Color fundus photograph.
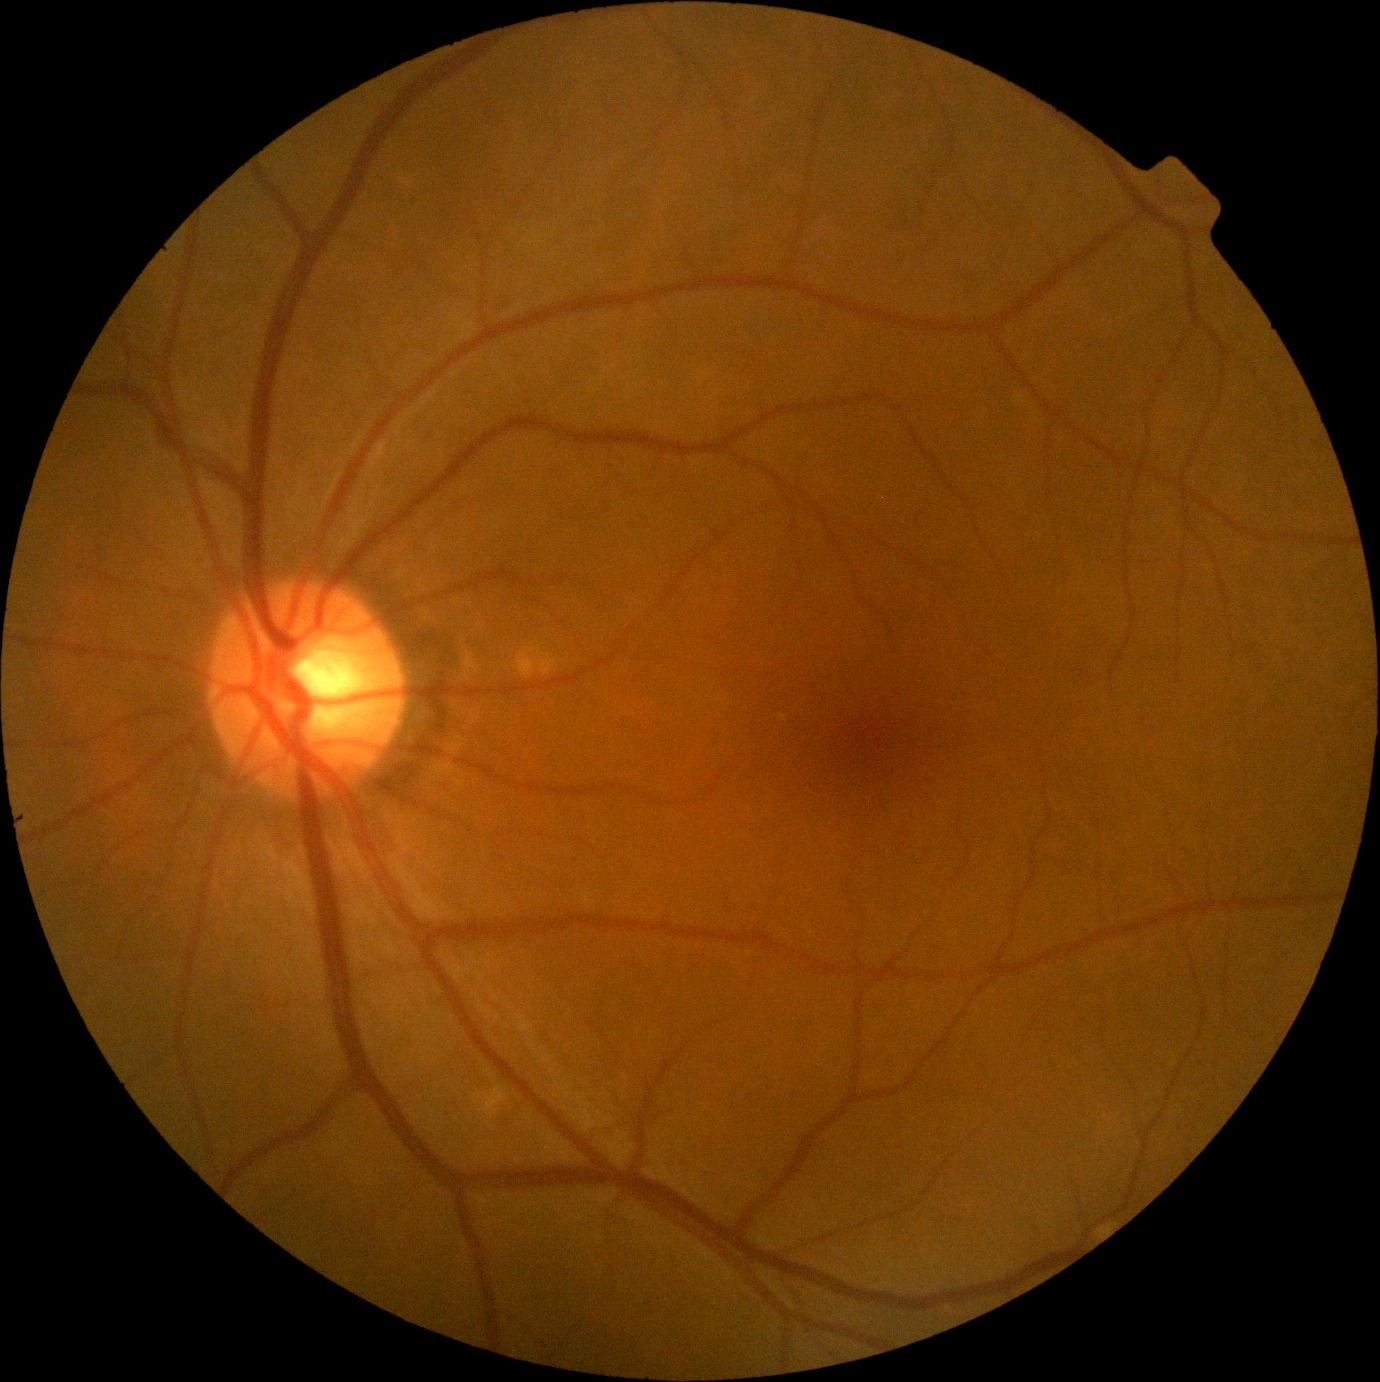

No diabetic retinal disease findings. Diabetic retinopathy: 0/4.